45° field of view: 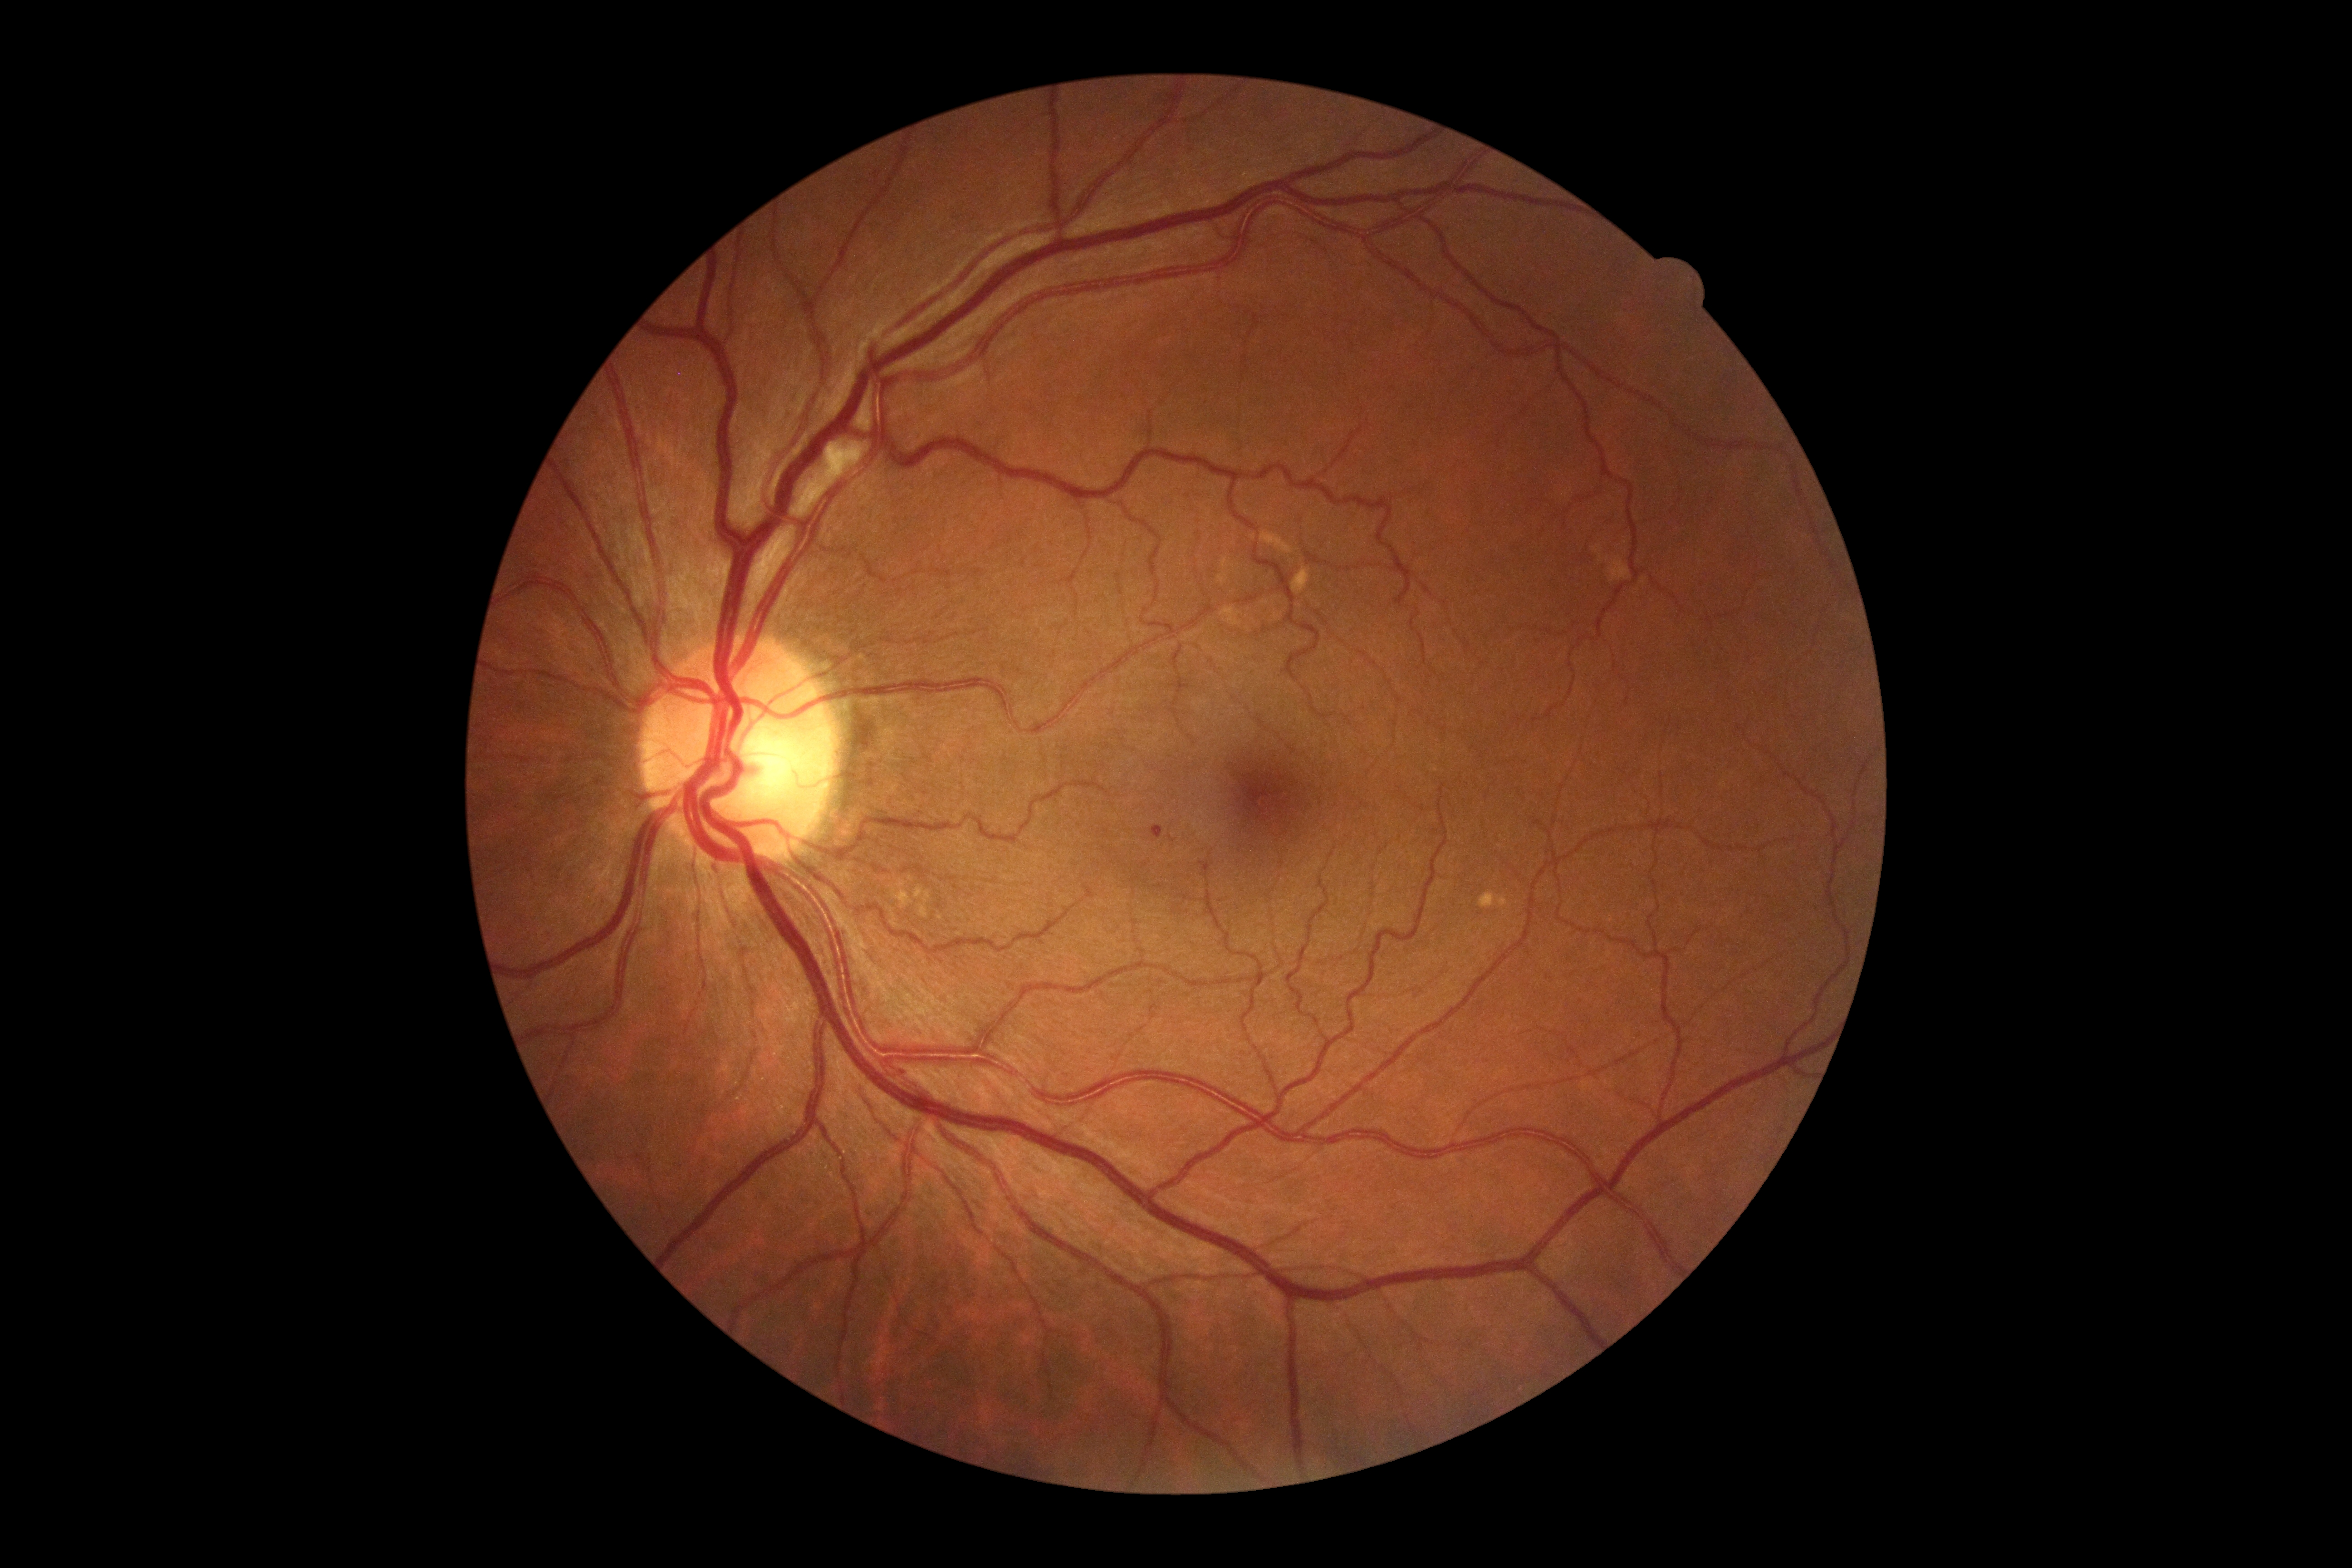

<lesions>
  <dr_grade>2</dr_grade>
  <ex />
  <ma>[1150, 825, 1165, 839]</ma>
  <ma_small_approx>(x=902, y=1070)</ma_small_approx>
  <se>[823, 441, 865, 470]</se>
  <he />
</lesions>